640 by 480 pixels. Infant wide-field retinal image. Acquired on the Clarity RetCam 3: 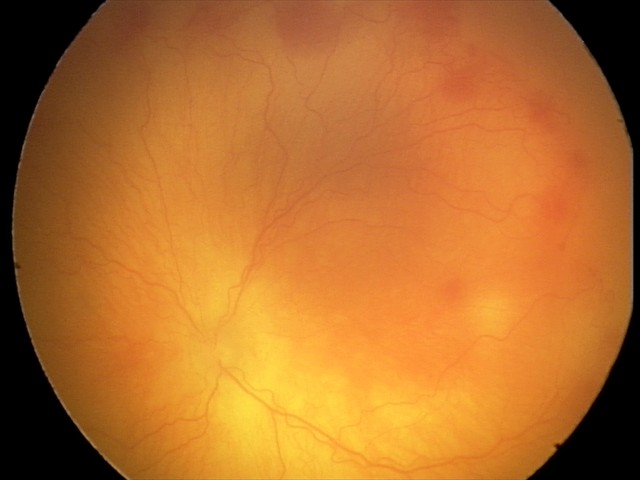

Series diagnosed as aggressive ROP (A-ROP). Plus disease was diagnosed.